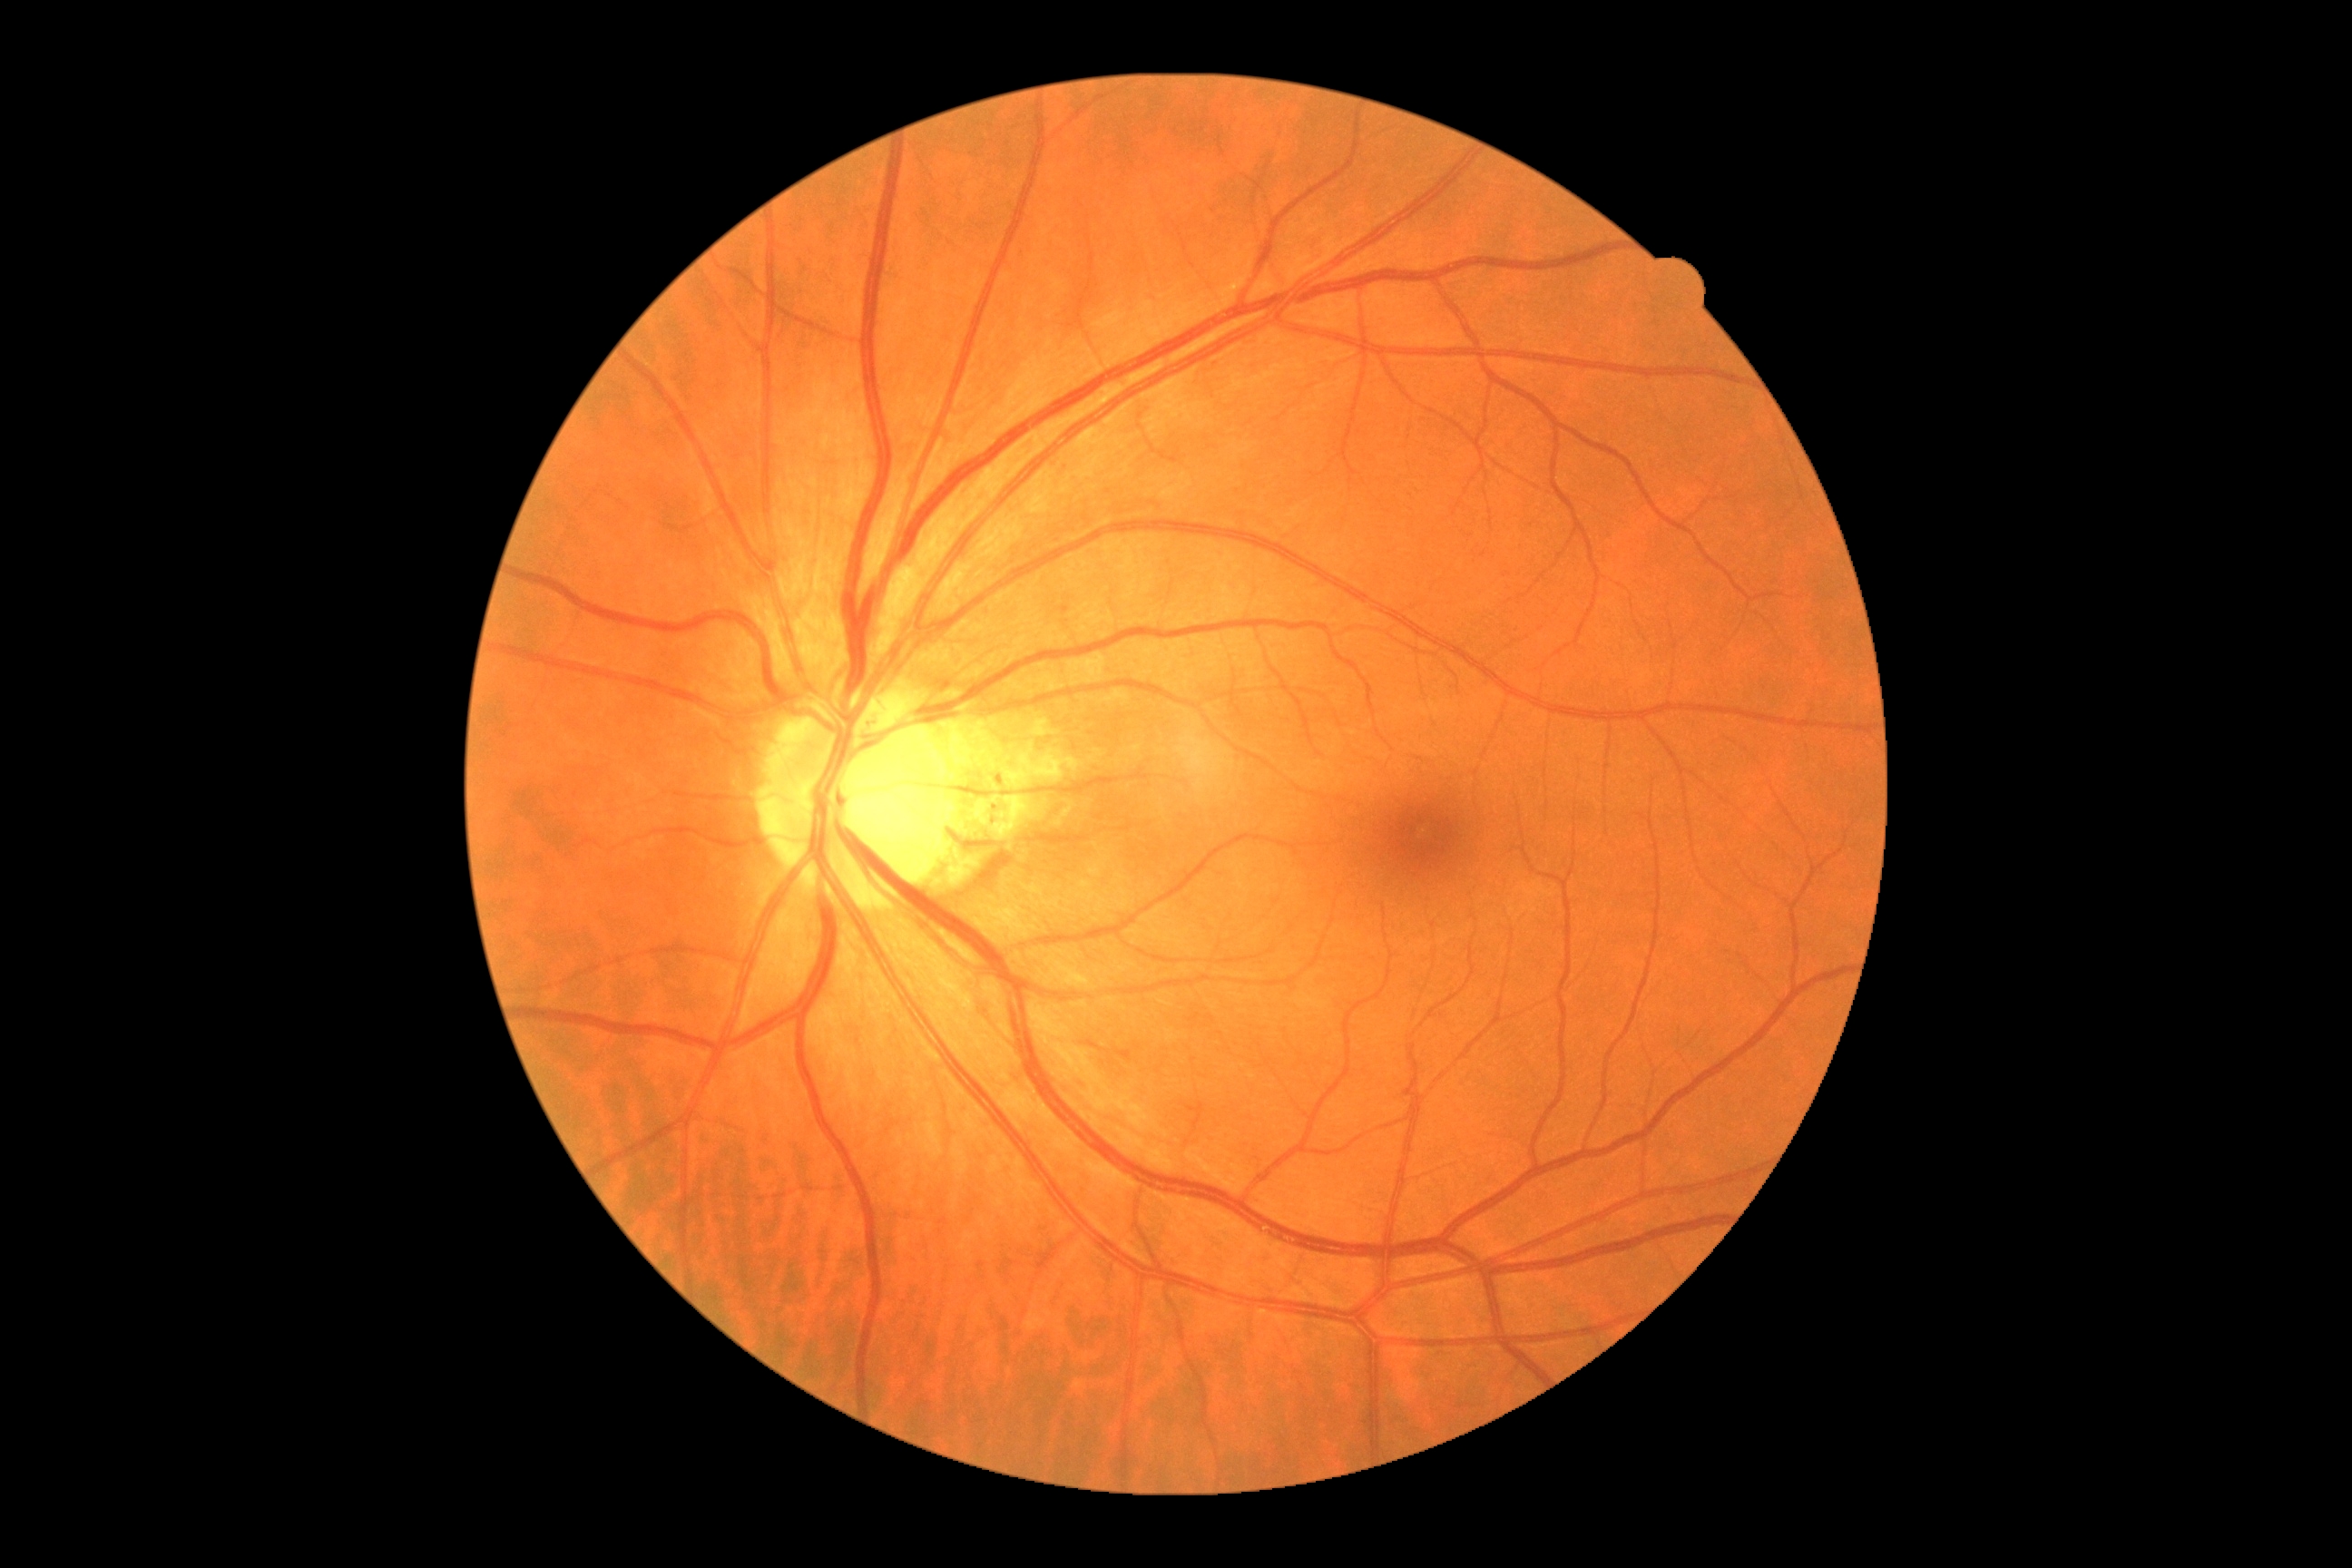 DR is grade 0 (no apparent retinopathy).